Pediatric wide-field fundus photograph.
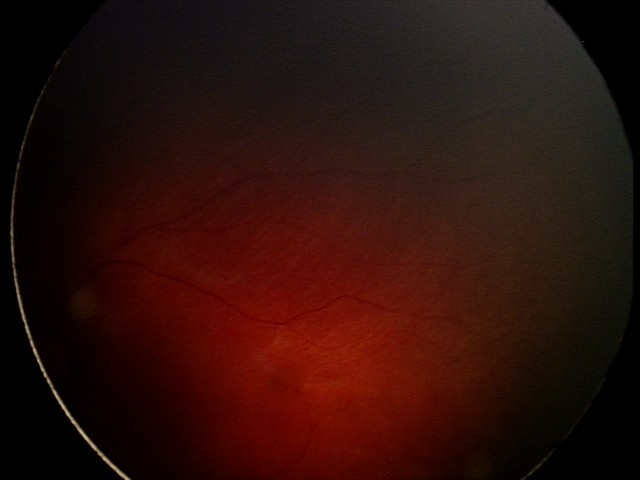

Screening series with retinal hemorrhages.